Image size 1924x1556 — 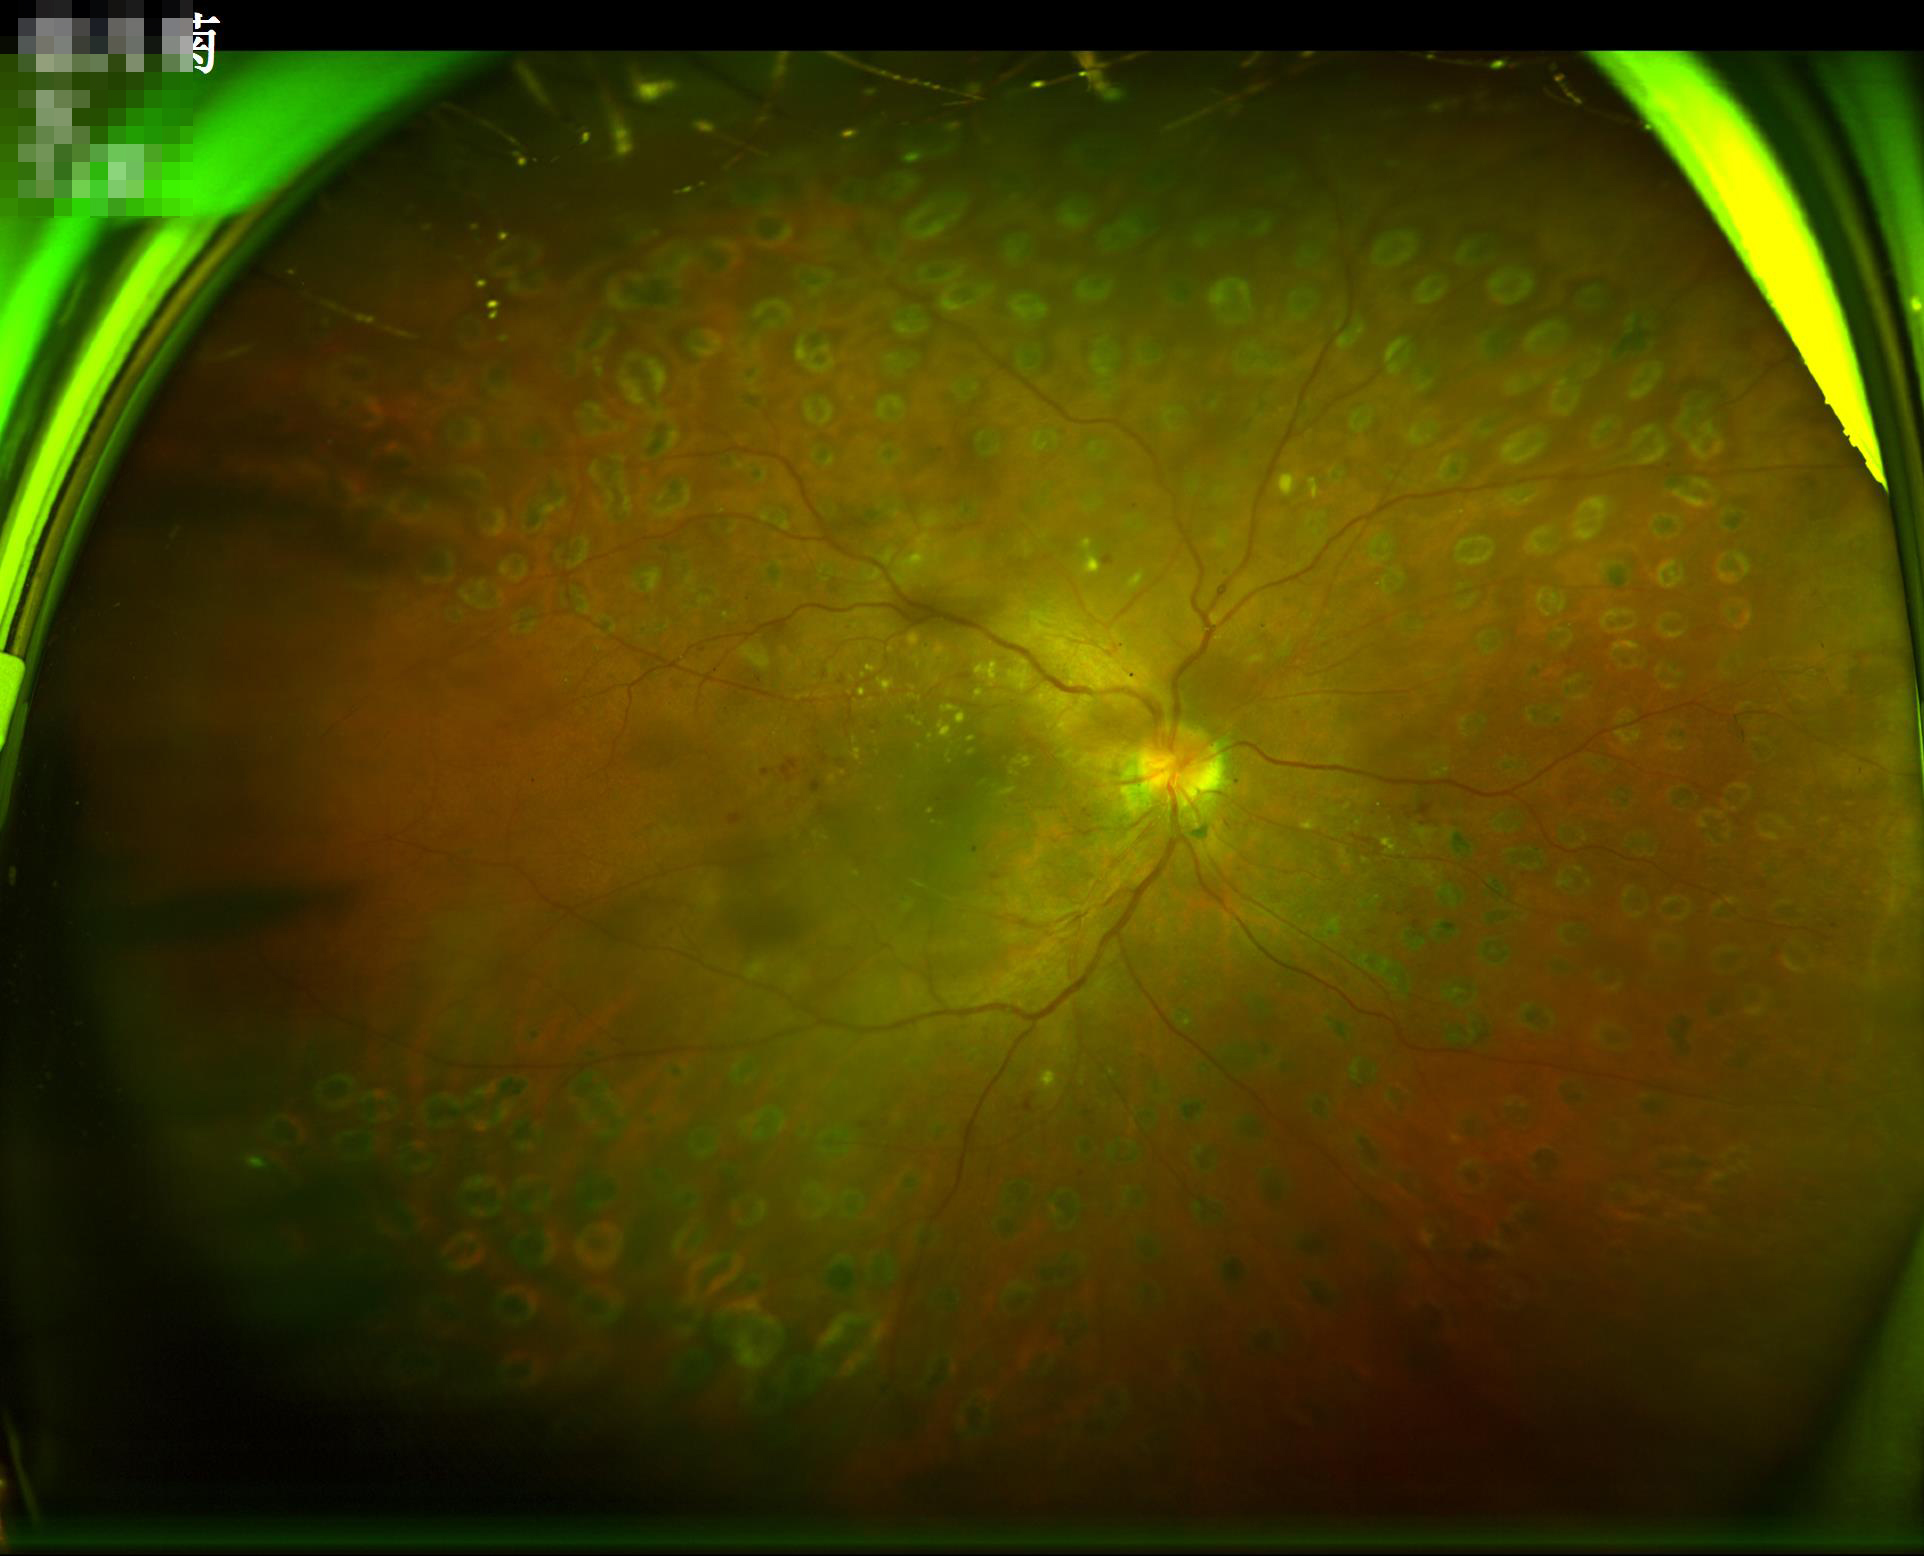

Overall image quality is good. The image is clear. Even illumination with no color cast.